2361 by 1568 pixels
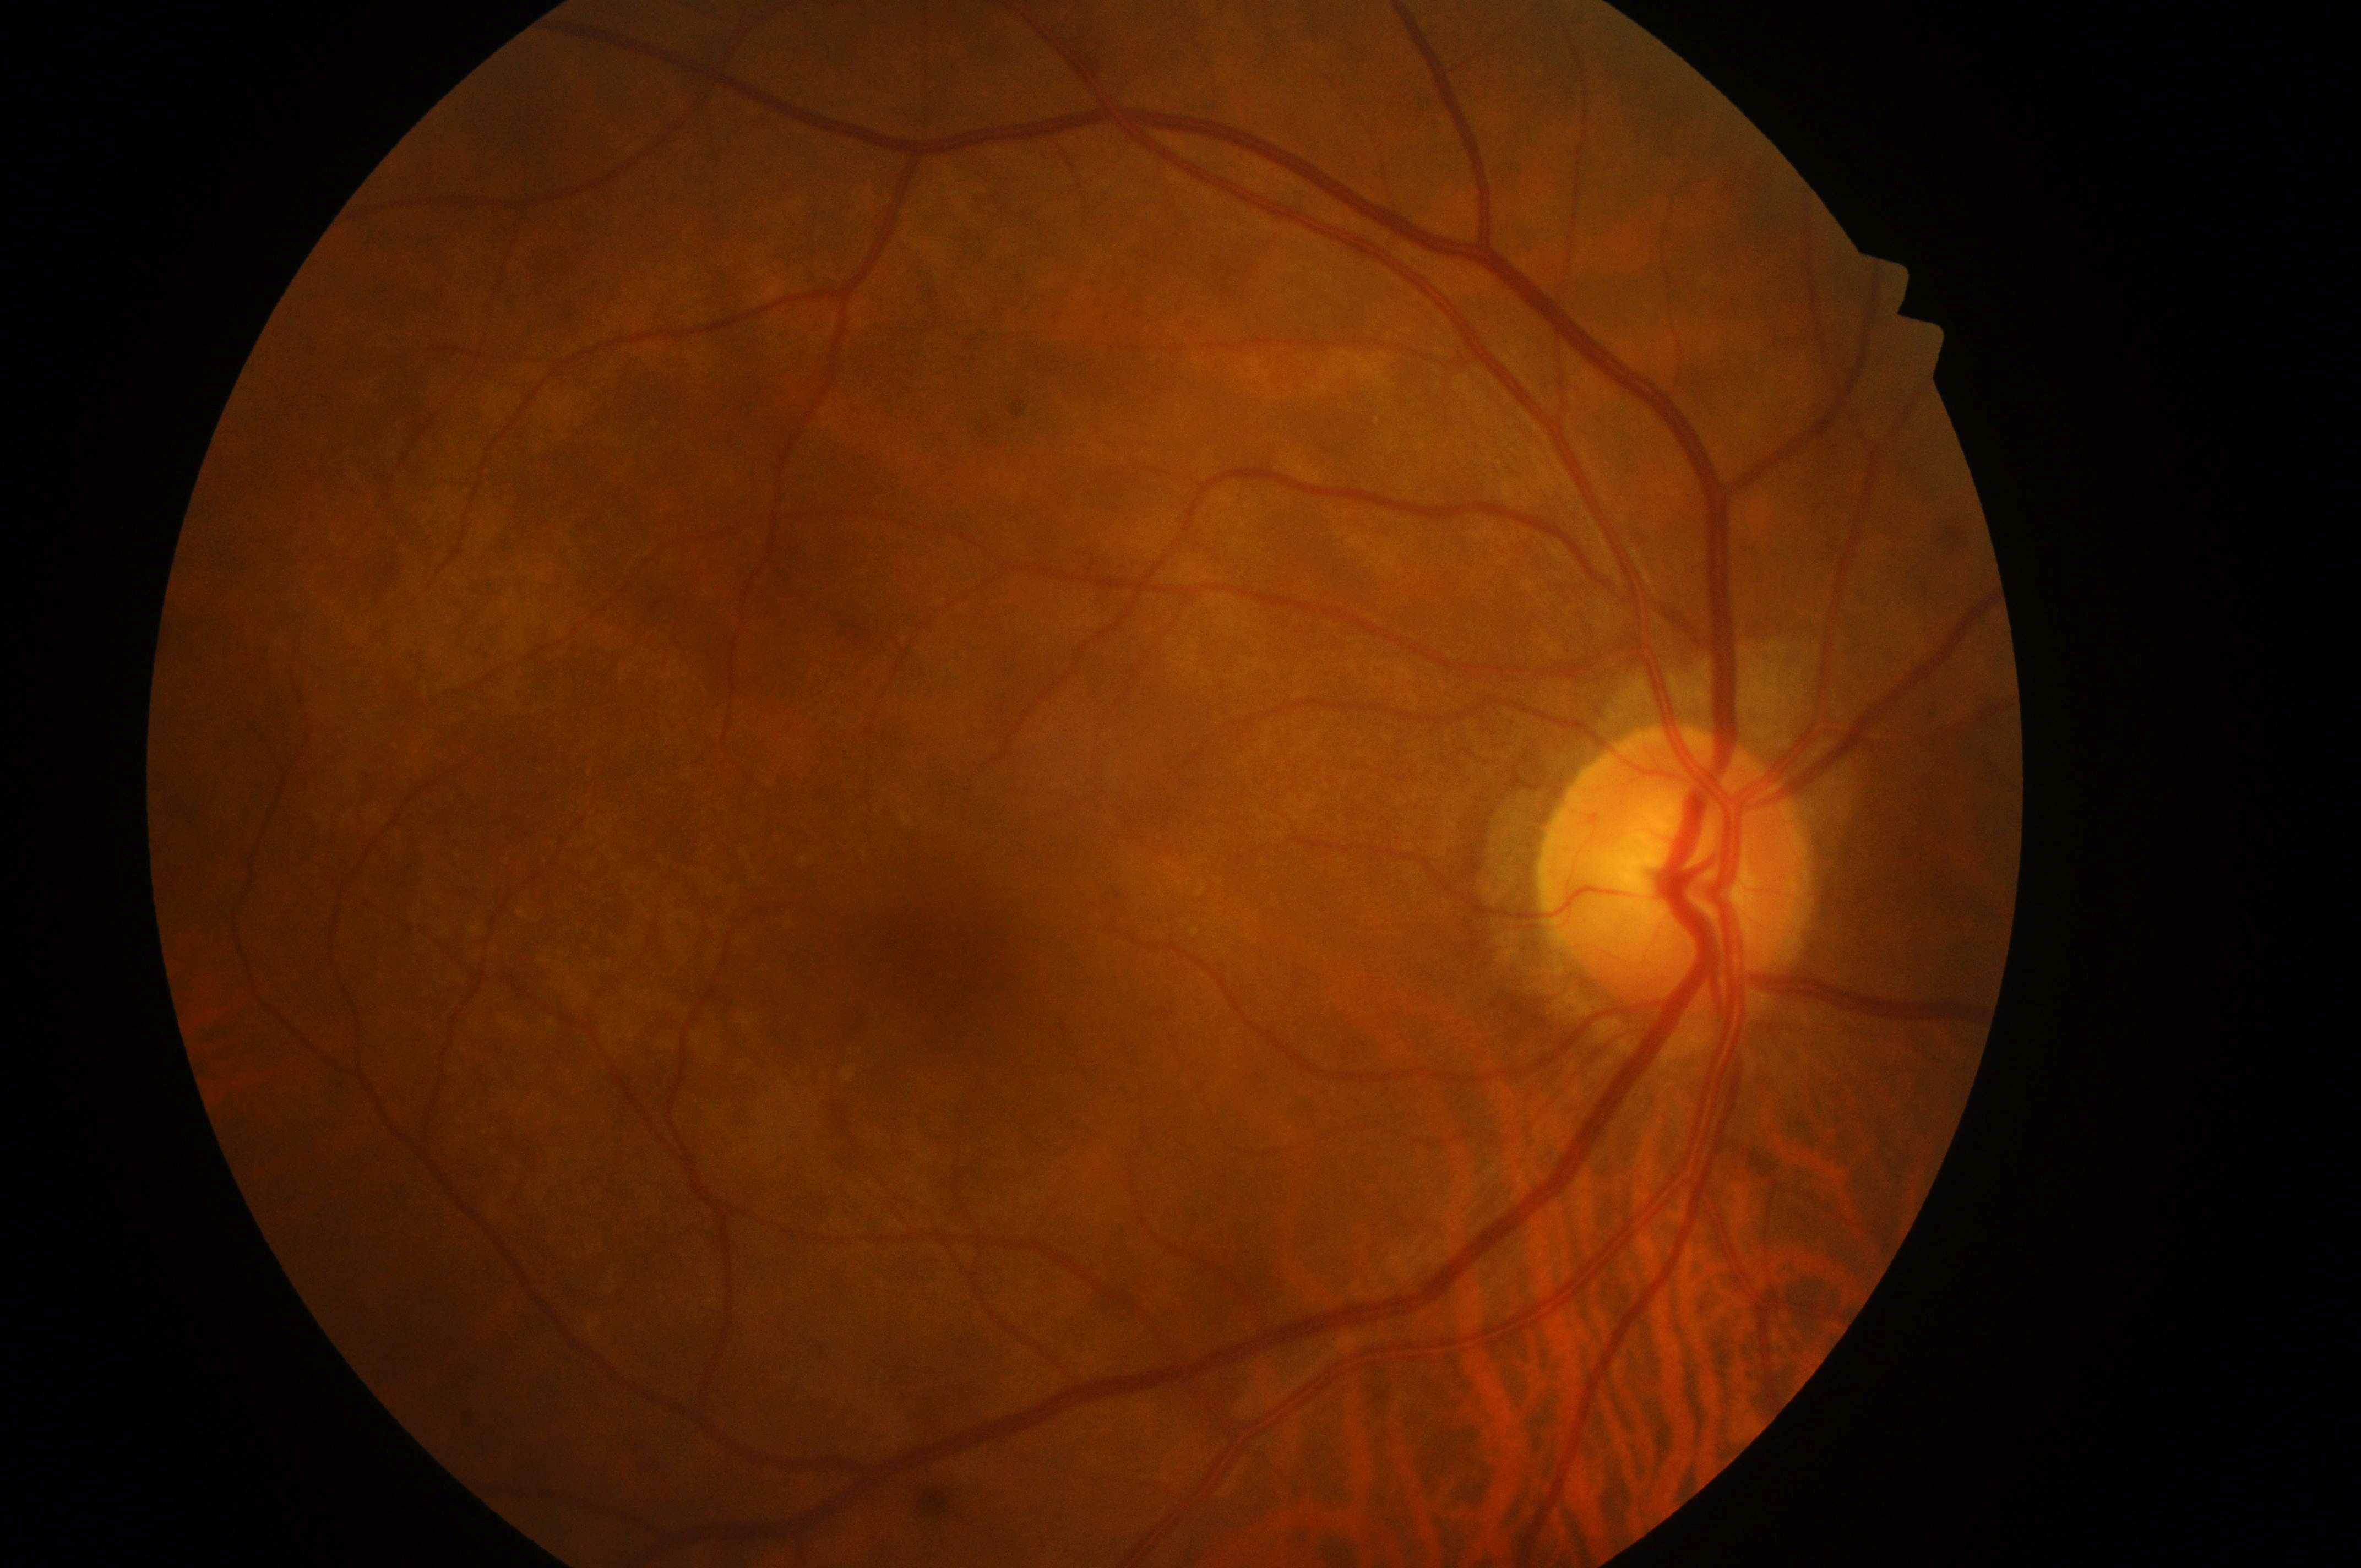 Macular center located at x=951, y=959. This is the OD. Optic disc: x=1671, y=880. Diabetic macular edema (DME) is 0. No DR or DME findings. Diabetic retinopathy (DR): 0/4.